FOV: 45 degrees. Acquired with a NIDEK AFC-230. 848x848. Posterior pole photograph — 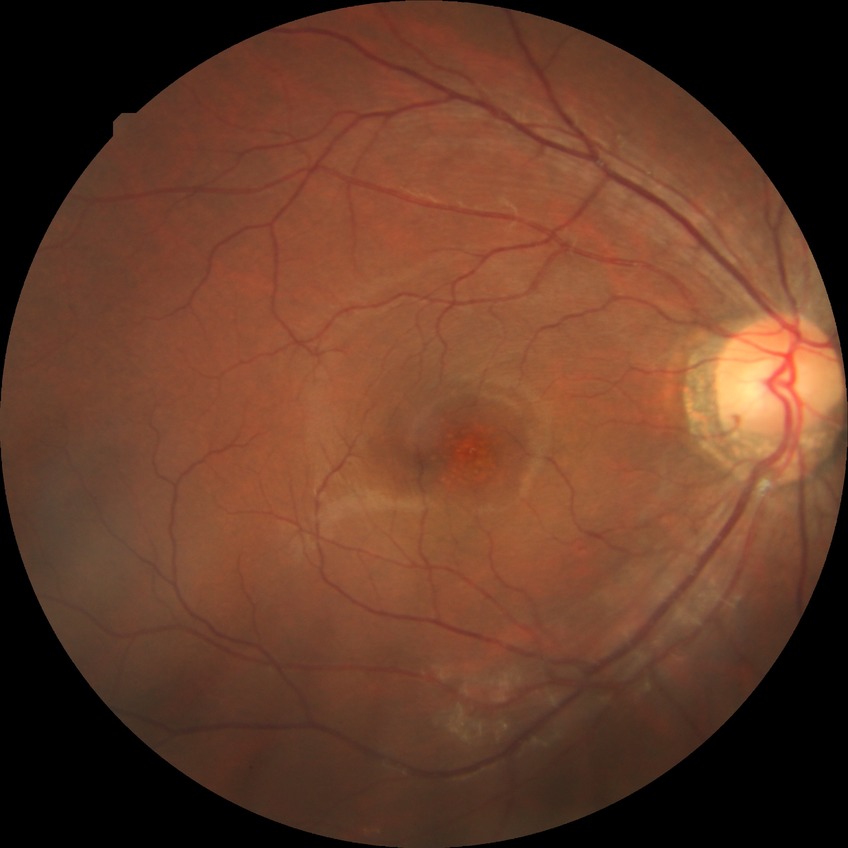 DR: NDR.